Wide-field fundus photograph from neonatal ROP screening · 640 by 480 pixels.
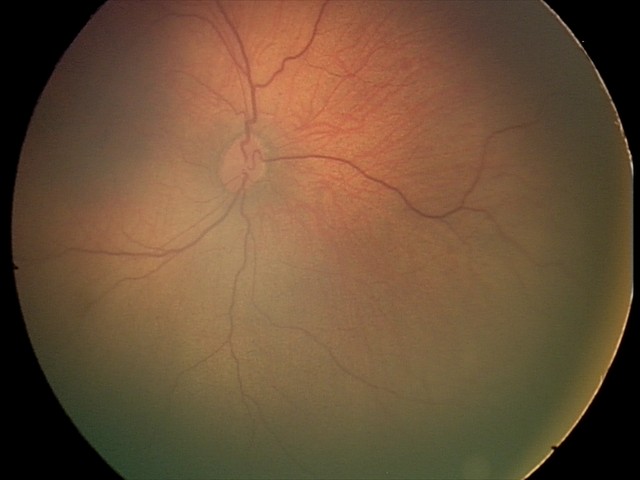

Q: What is the screening diagnosis?
A: normal fundus examination